Ultra-widefield fundus photograph.
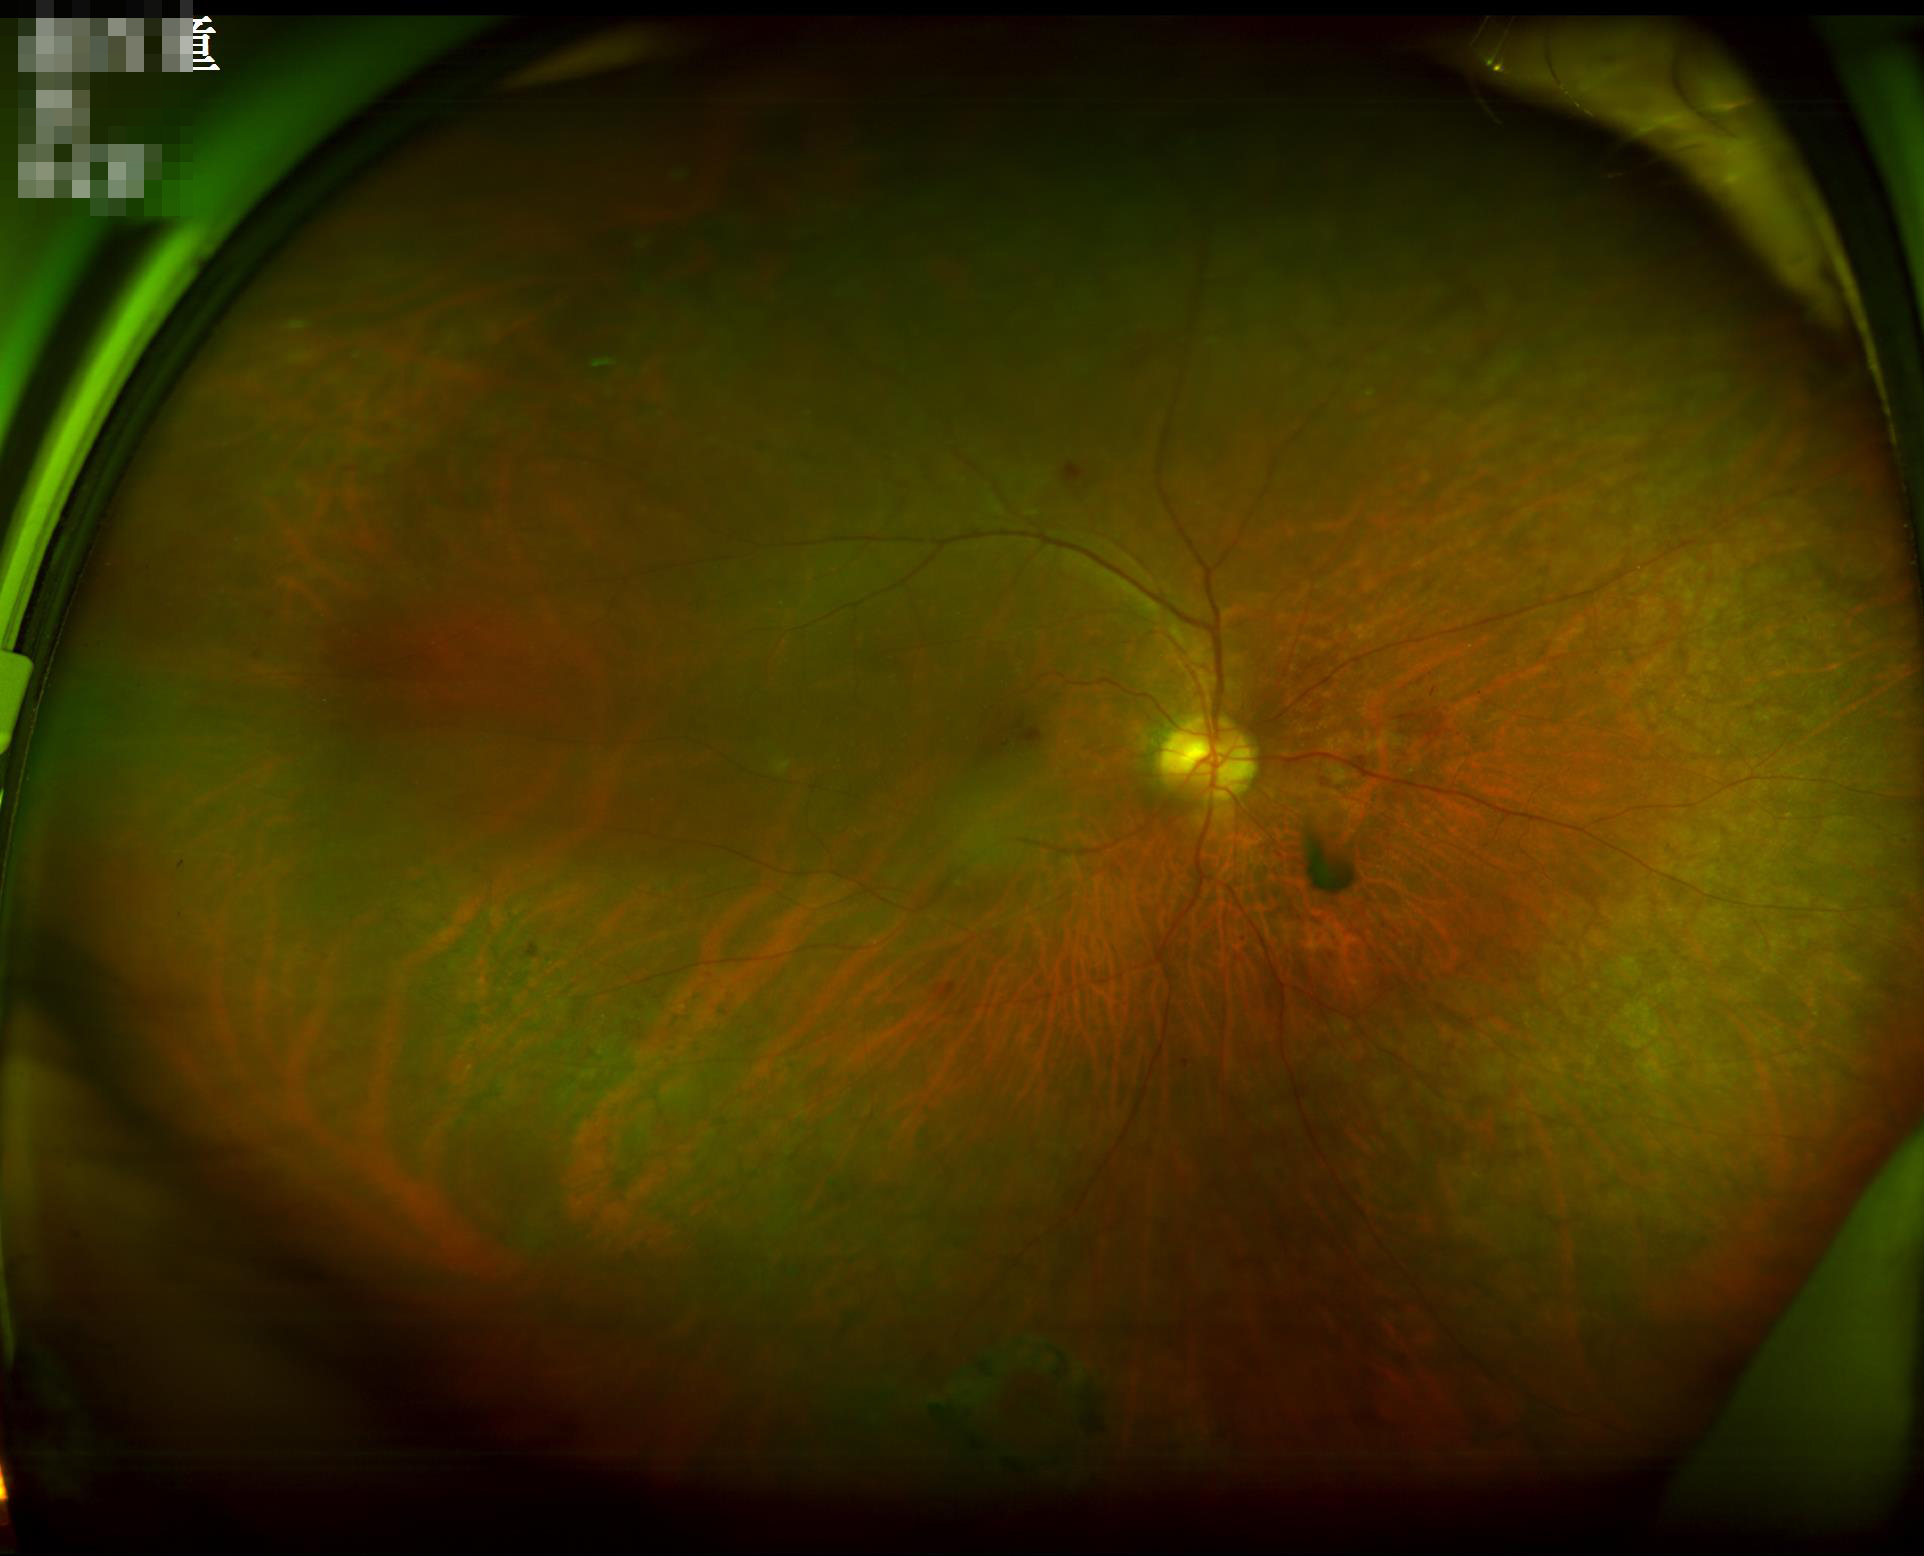

Overall = adequate; Contrast = satisfactory; Focus = sharp.